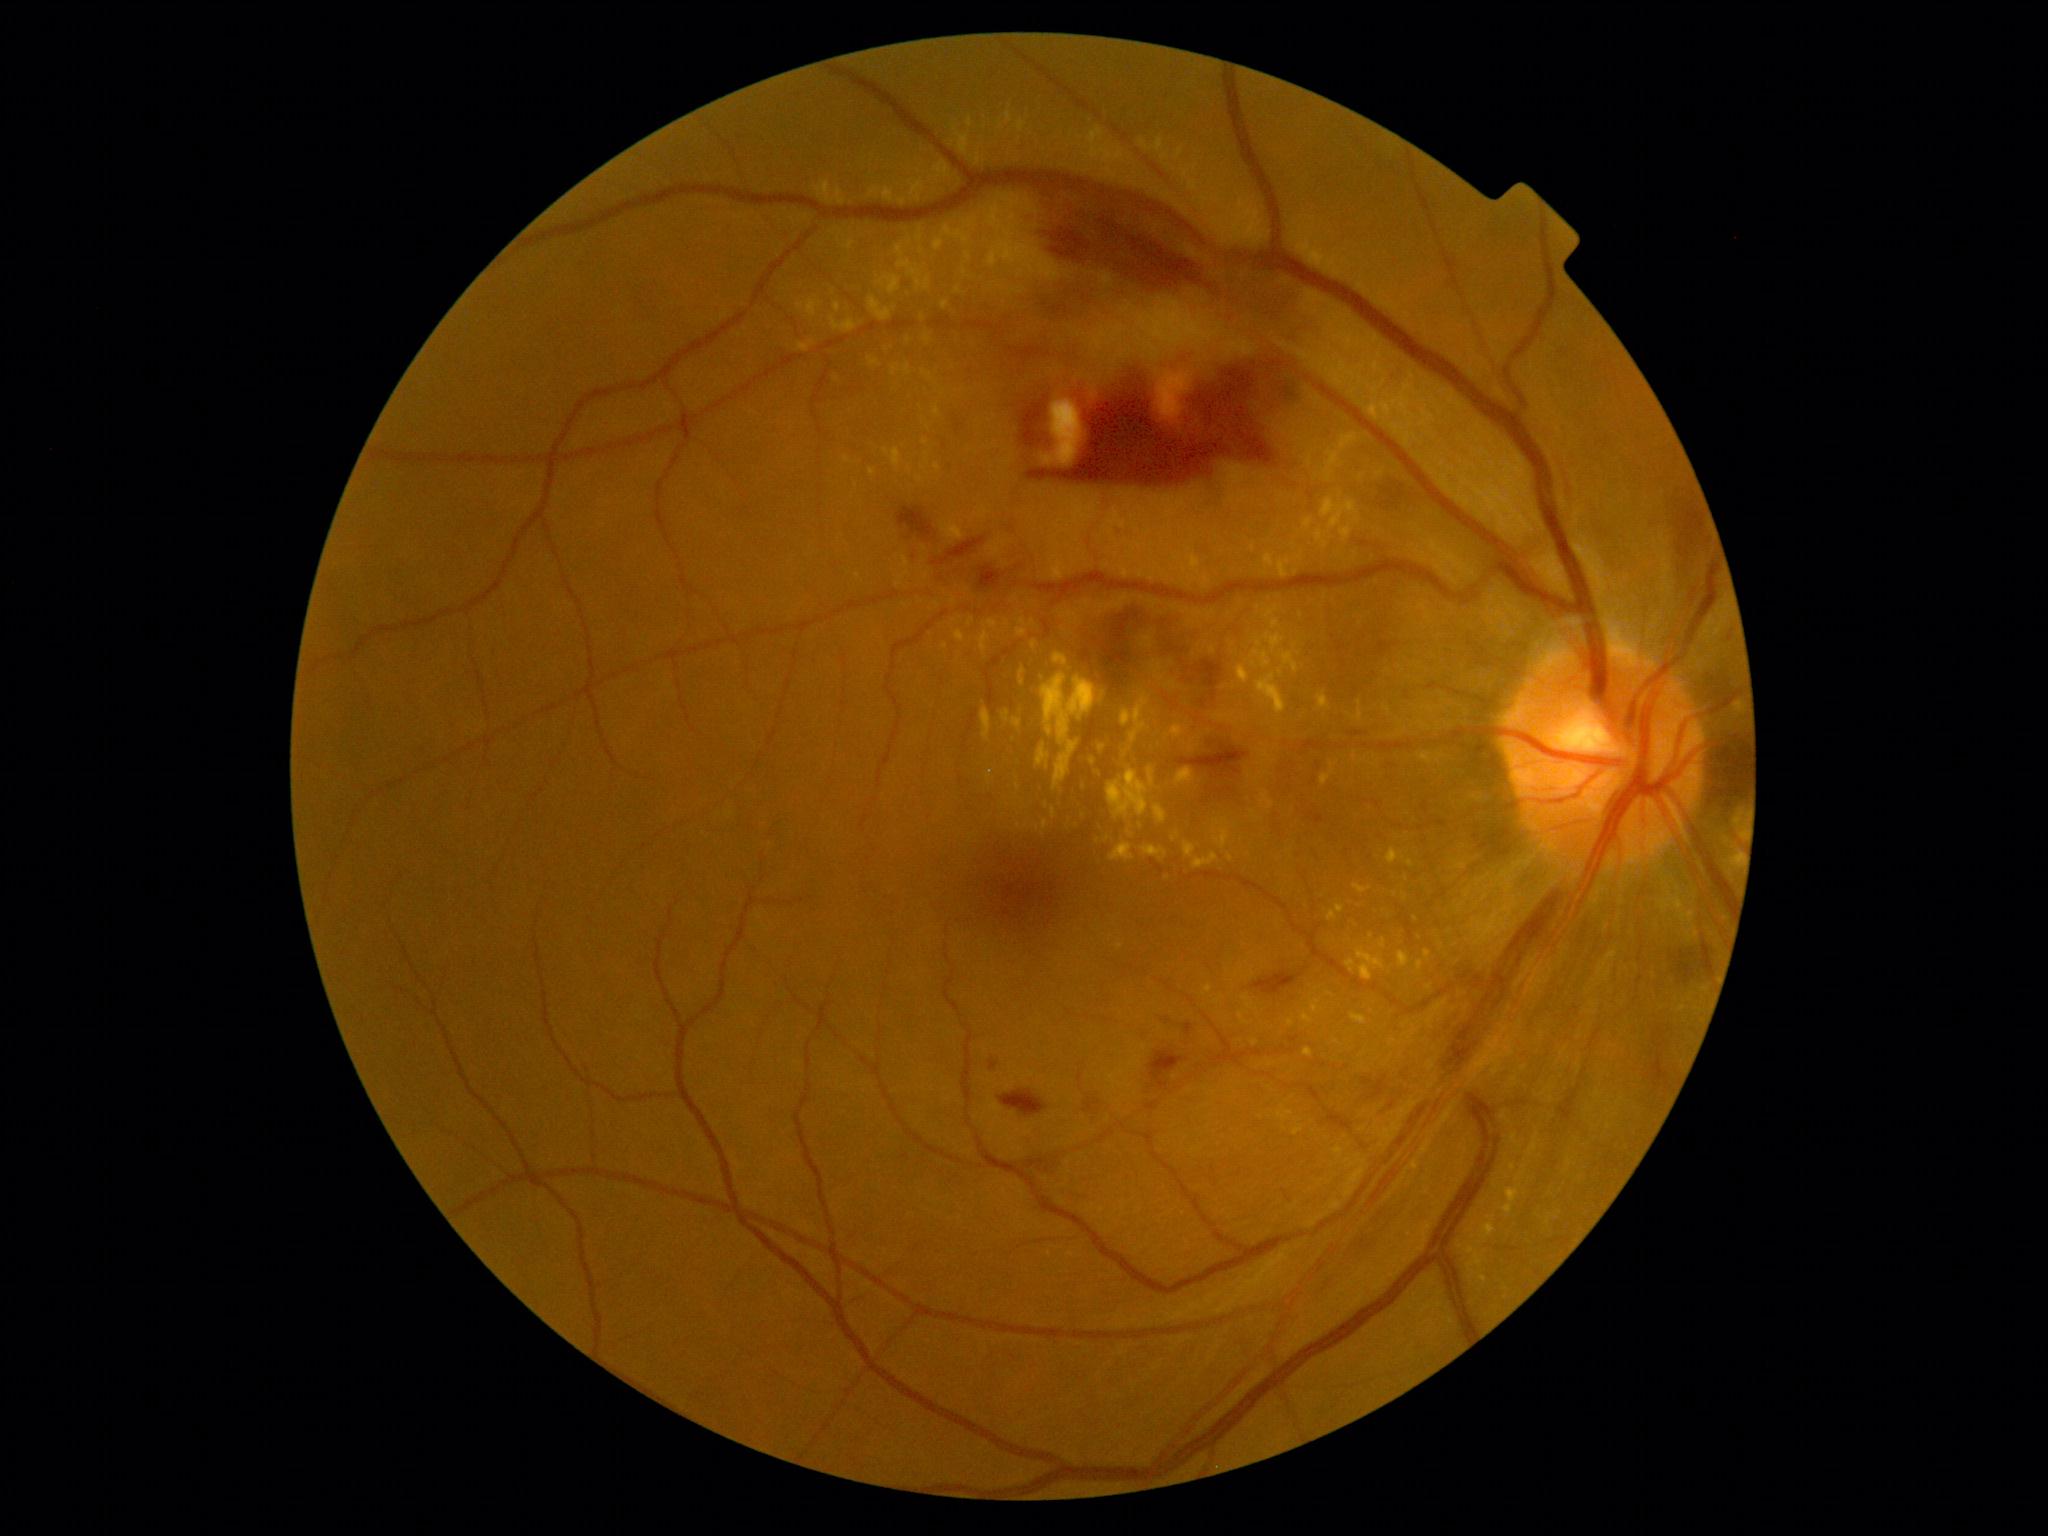
Retinopathy is grade 2.